Camera: Nidek AFC-330 · 240x240:
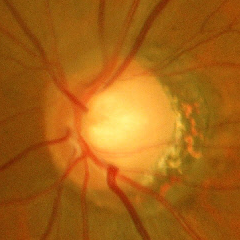

Glaucoma is present. Demonstrates early glaucomatous changes.